Captured with the Phoenix ICON (100° field of view). Wide-field contact fundus photograph of an infant — 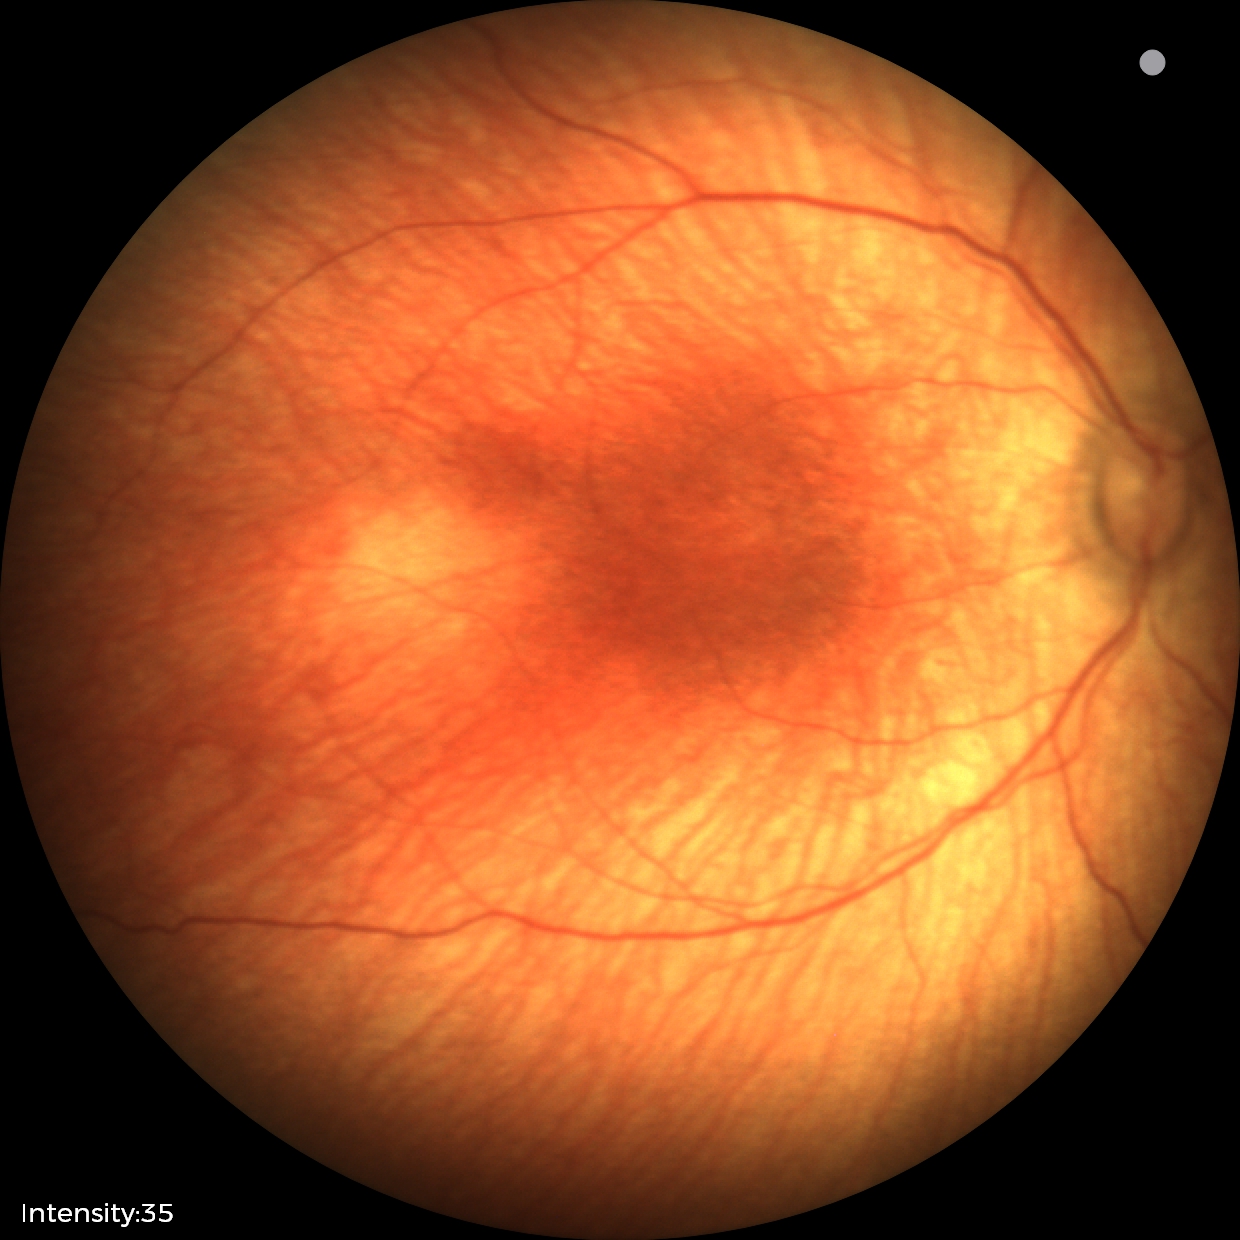

Examination diagnosed as status post retinopathy of prematurity.